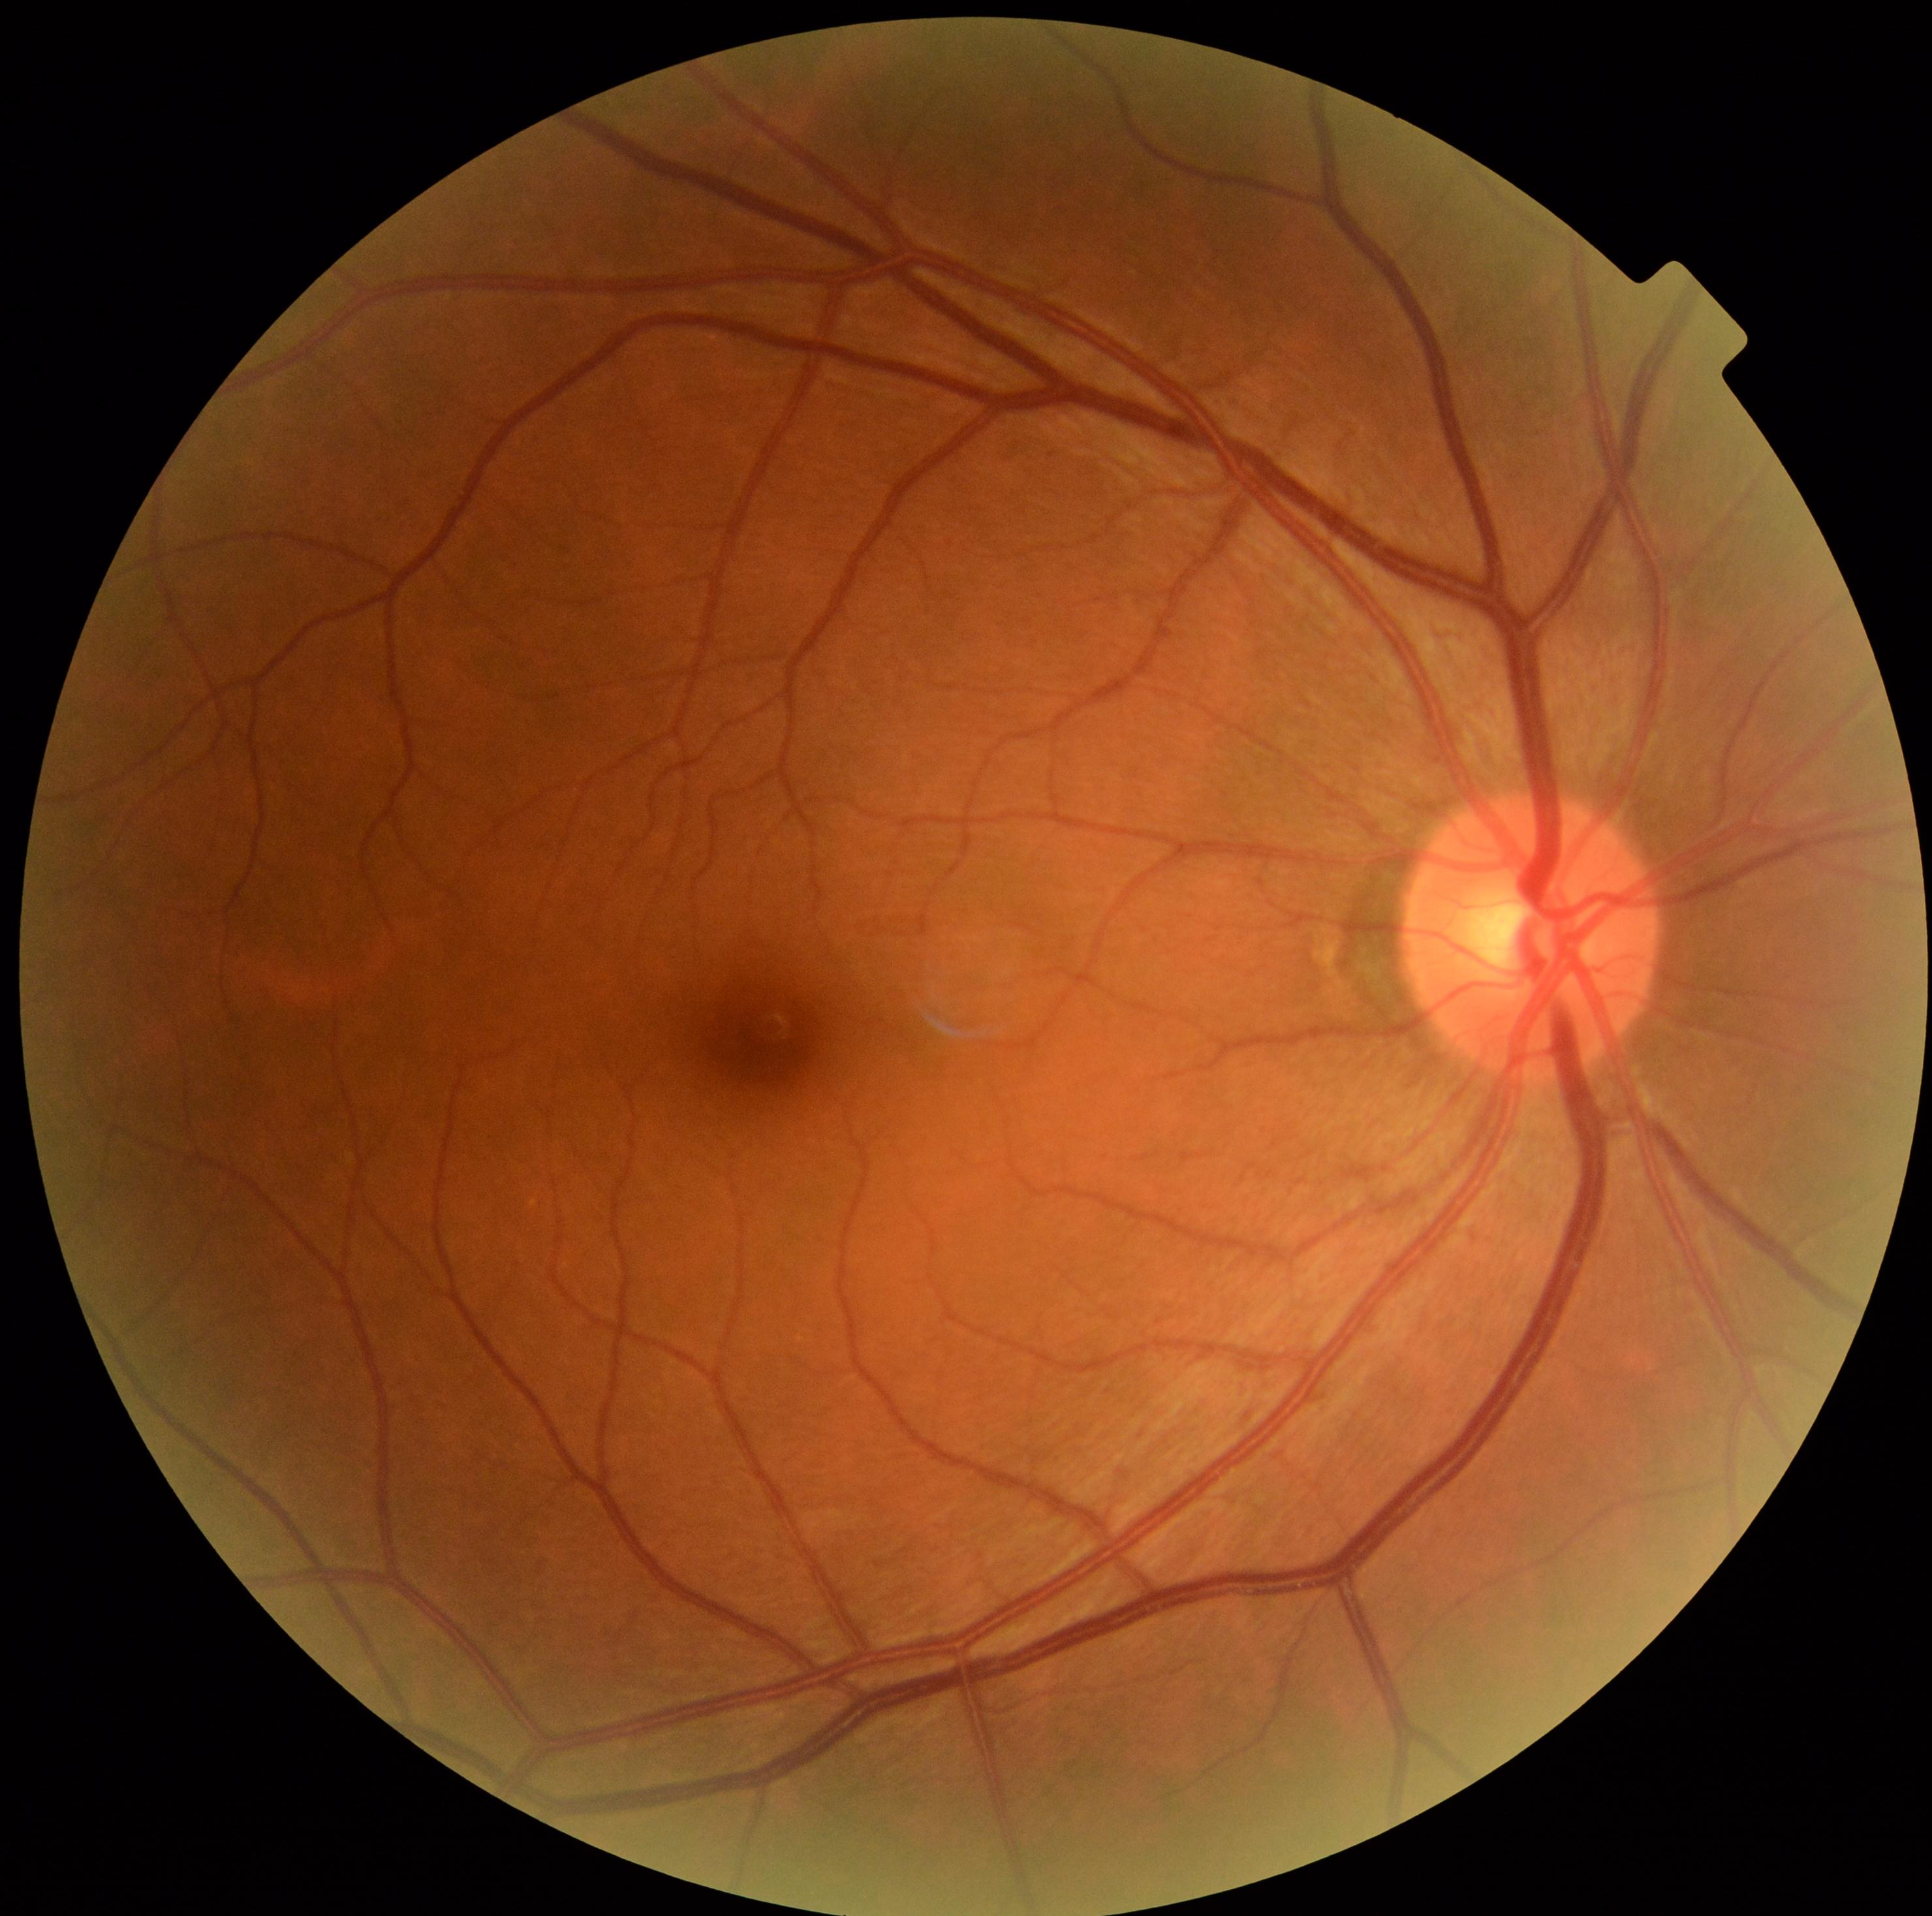

Diabetic retinopathy grade is no apparent diabetic retinopathy (0) — no visible signs of diabetic retinopathy.